Nonmydriatic. 45 degree fundus photograph. Color fundus photograph:
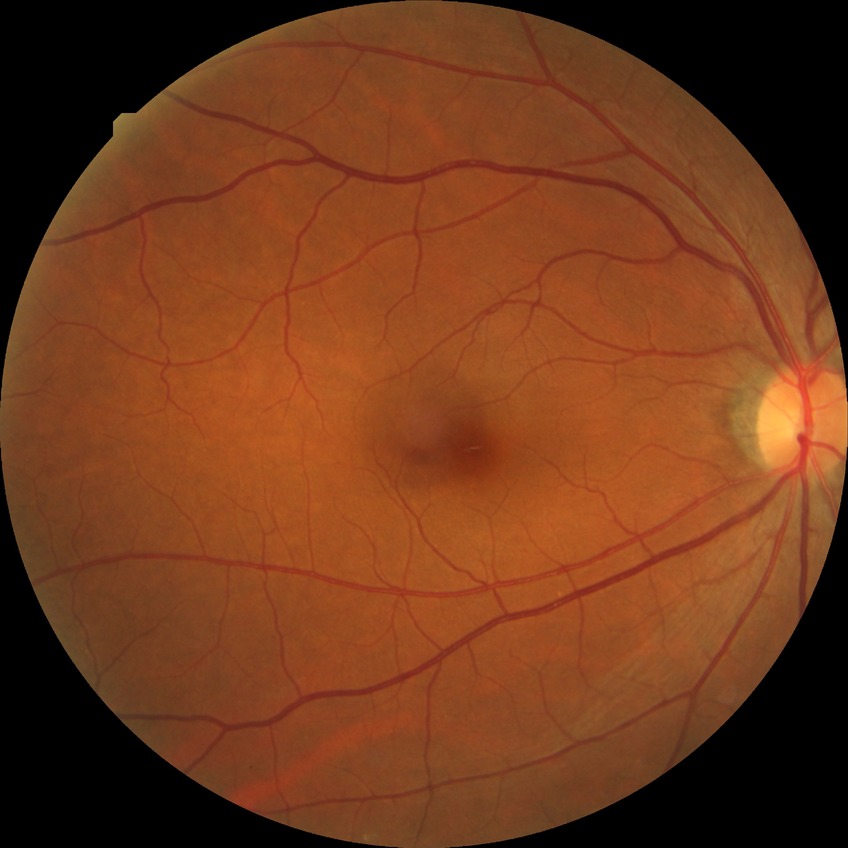

Diabetic retinopathy stage: no diabetic retinopathy.